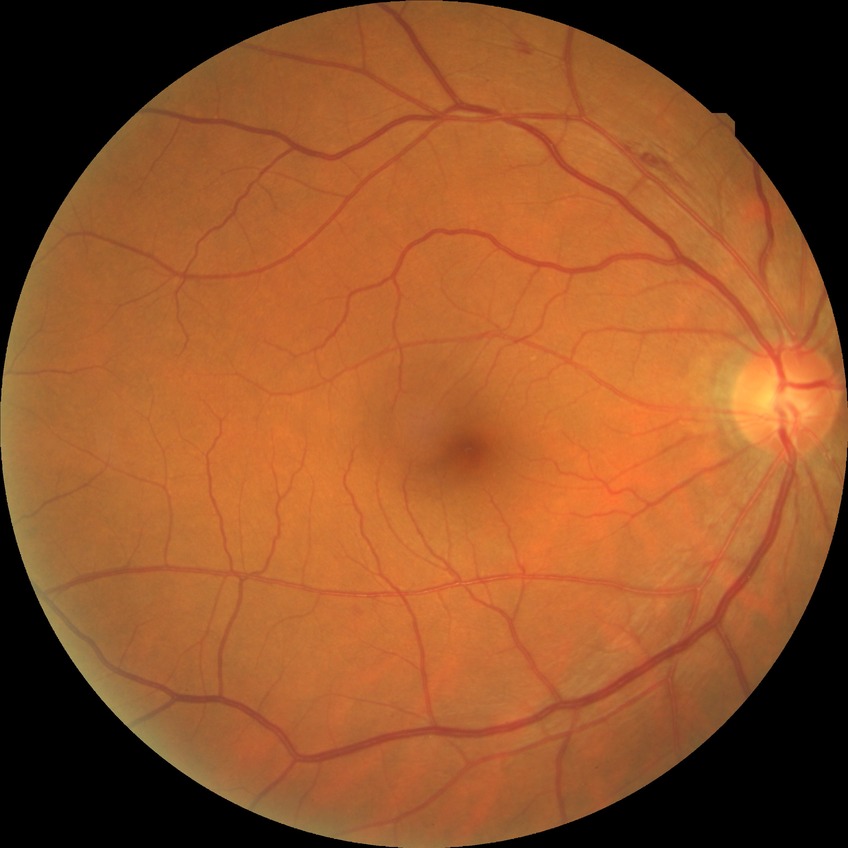 Retinopathy stage: simple diabetic retinopathy.